FOV: 45 degrees, 2352x1568, color fundus photograph — 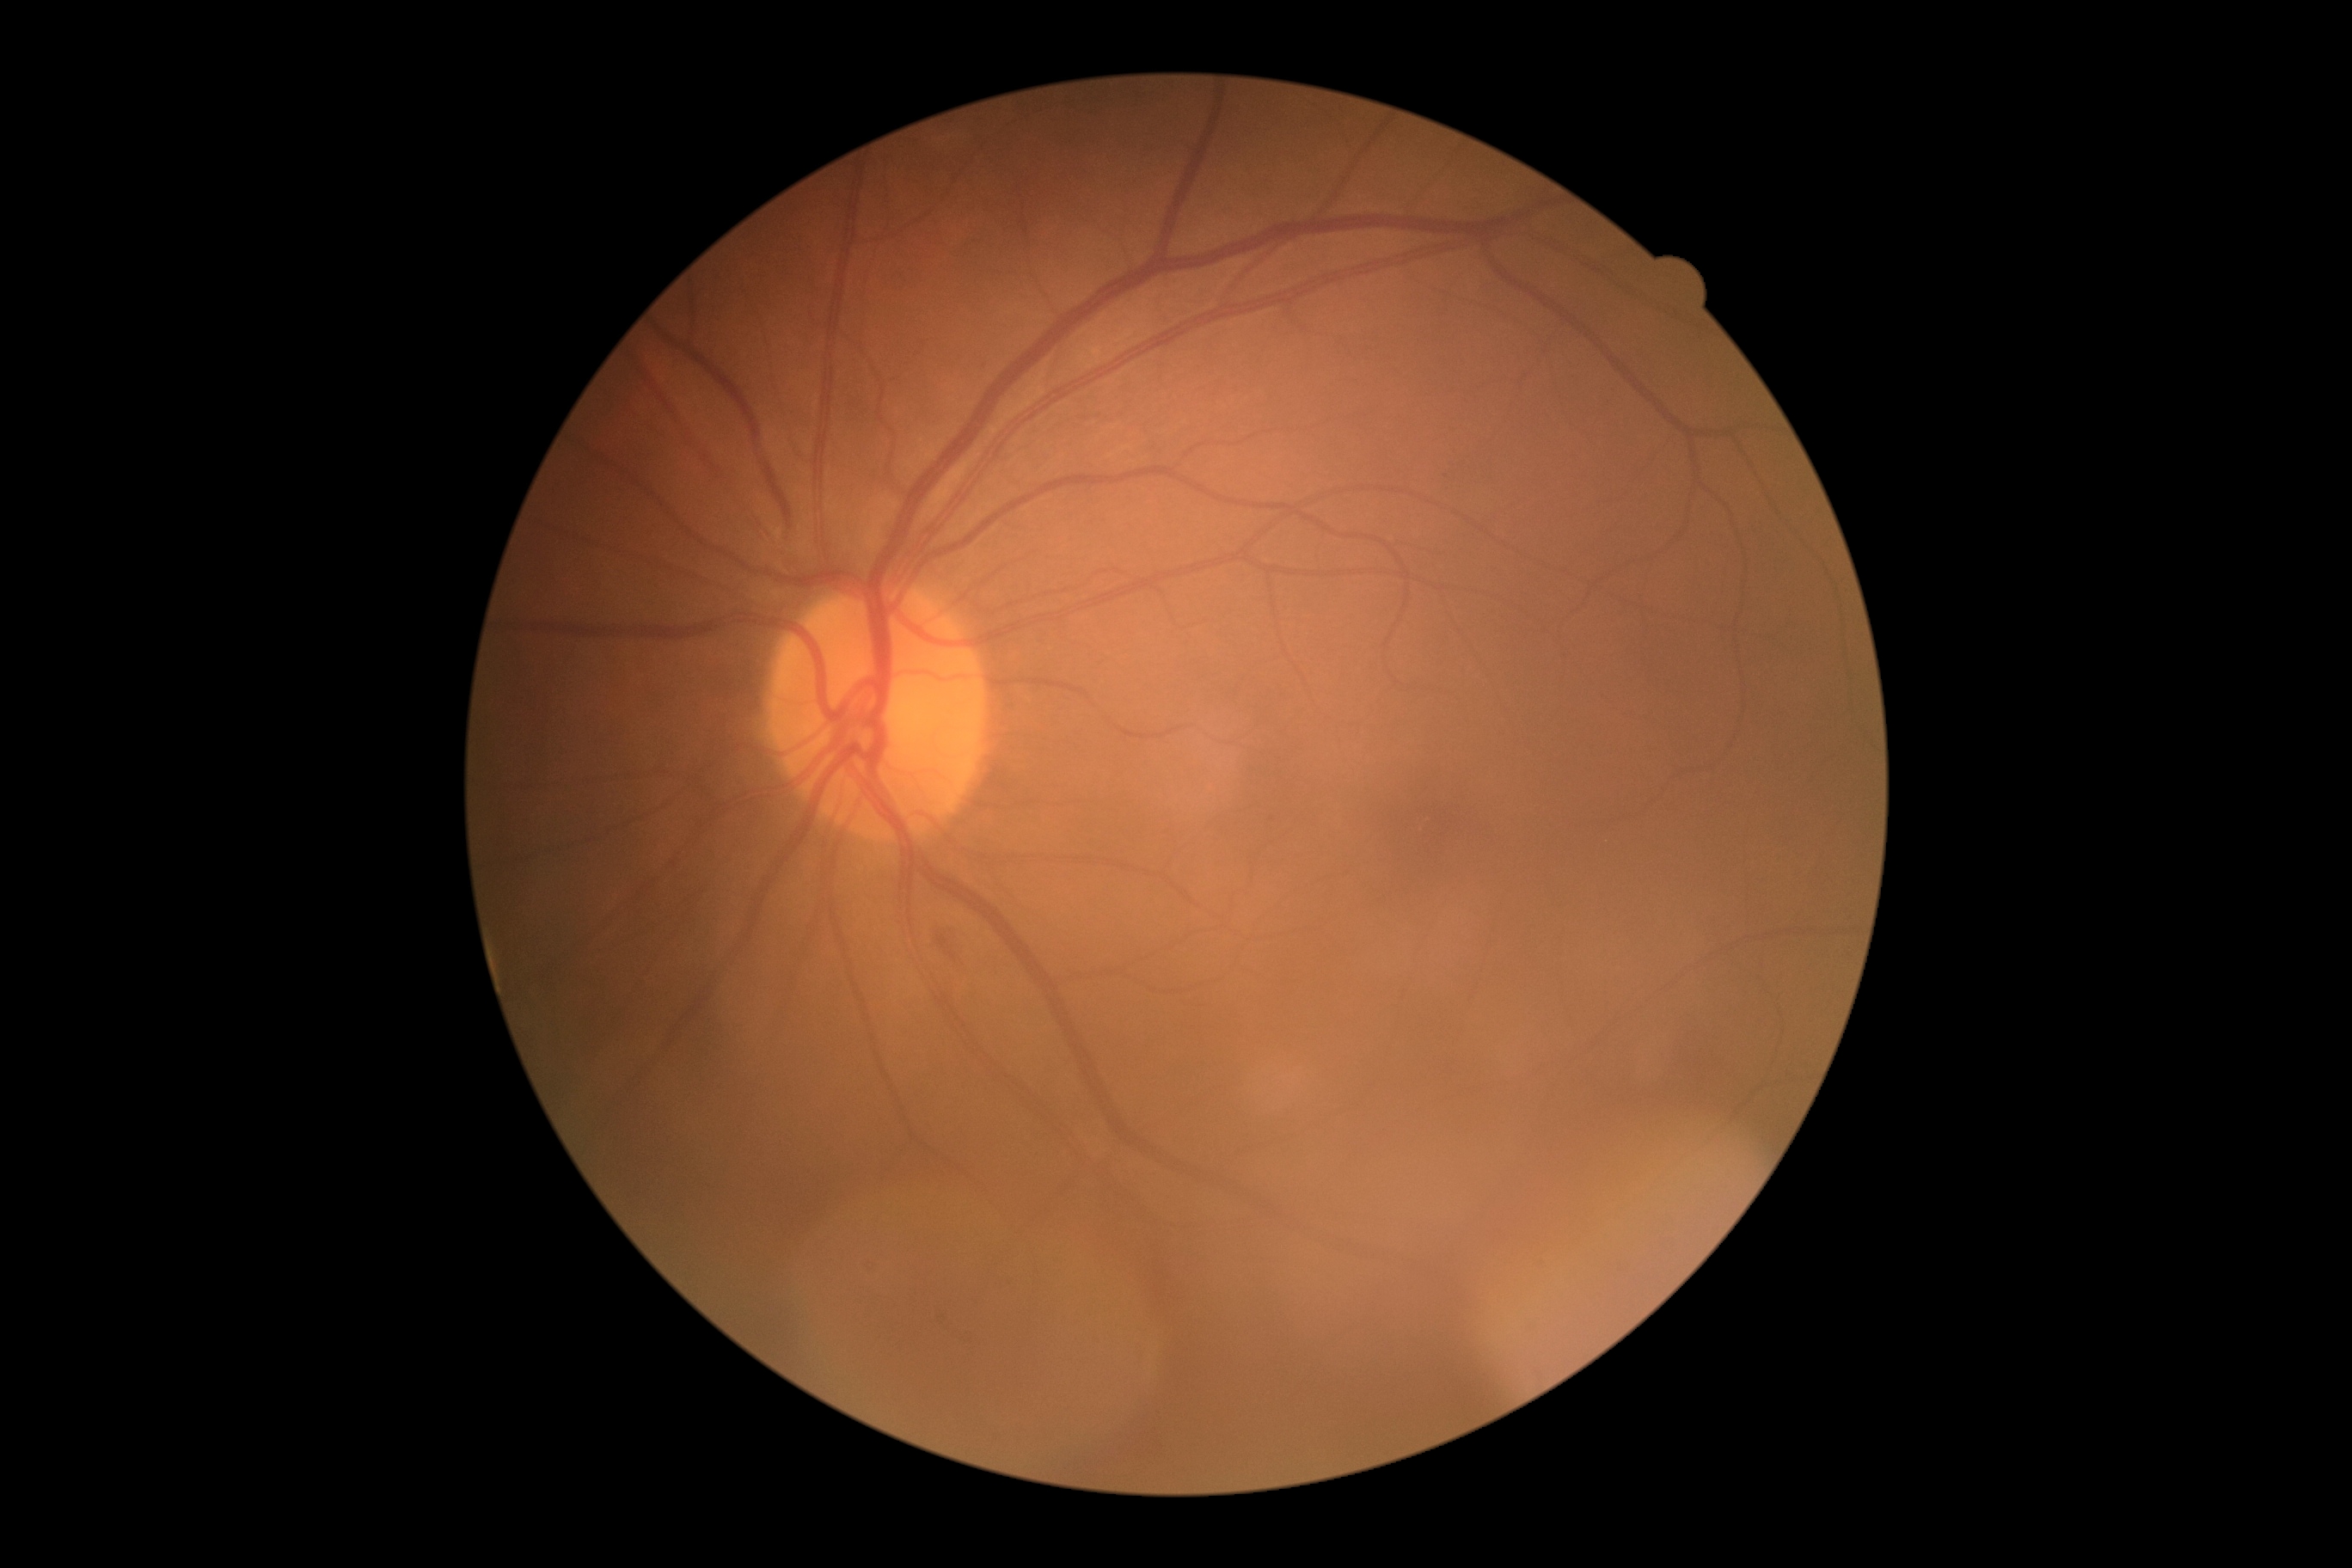 Findings:
– DR grade — 2